Color fundus image · 50-degree field of view.
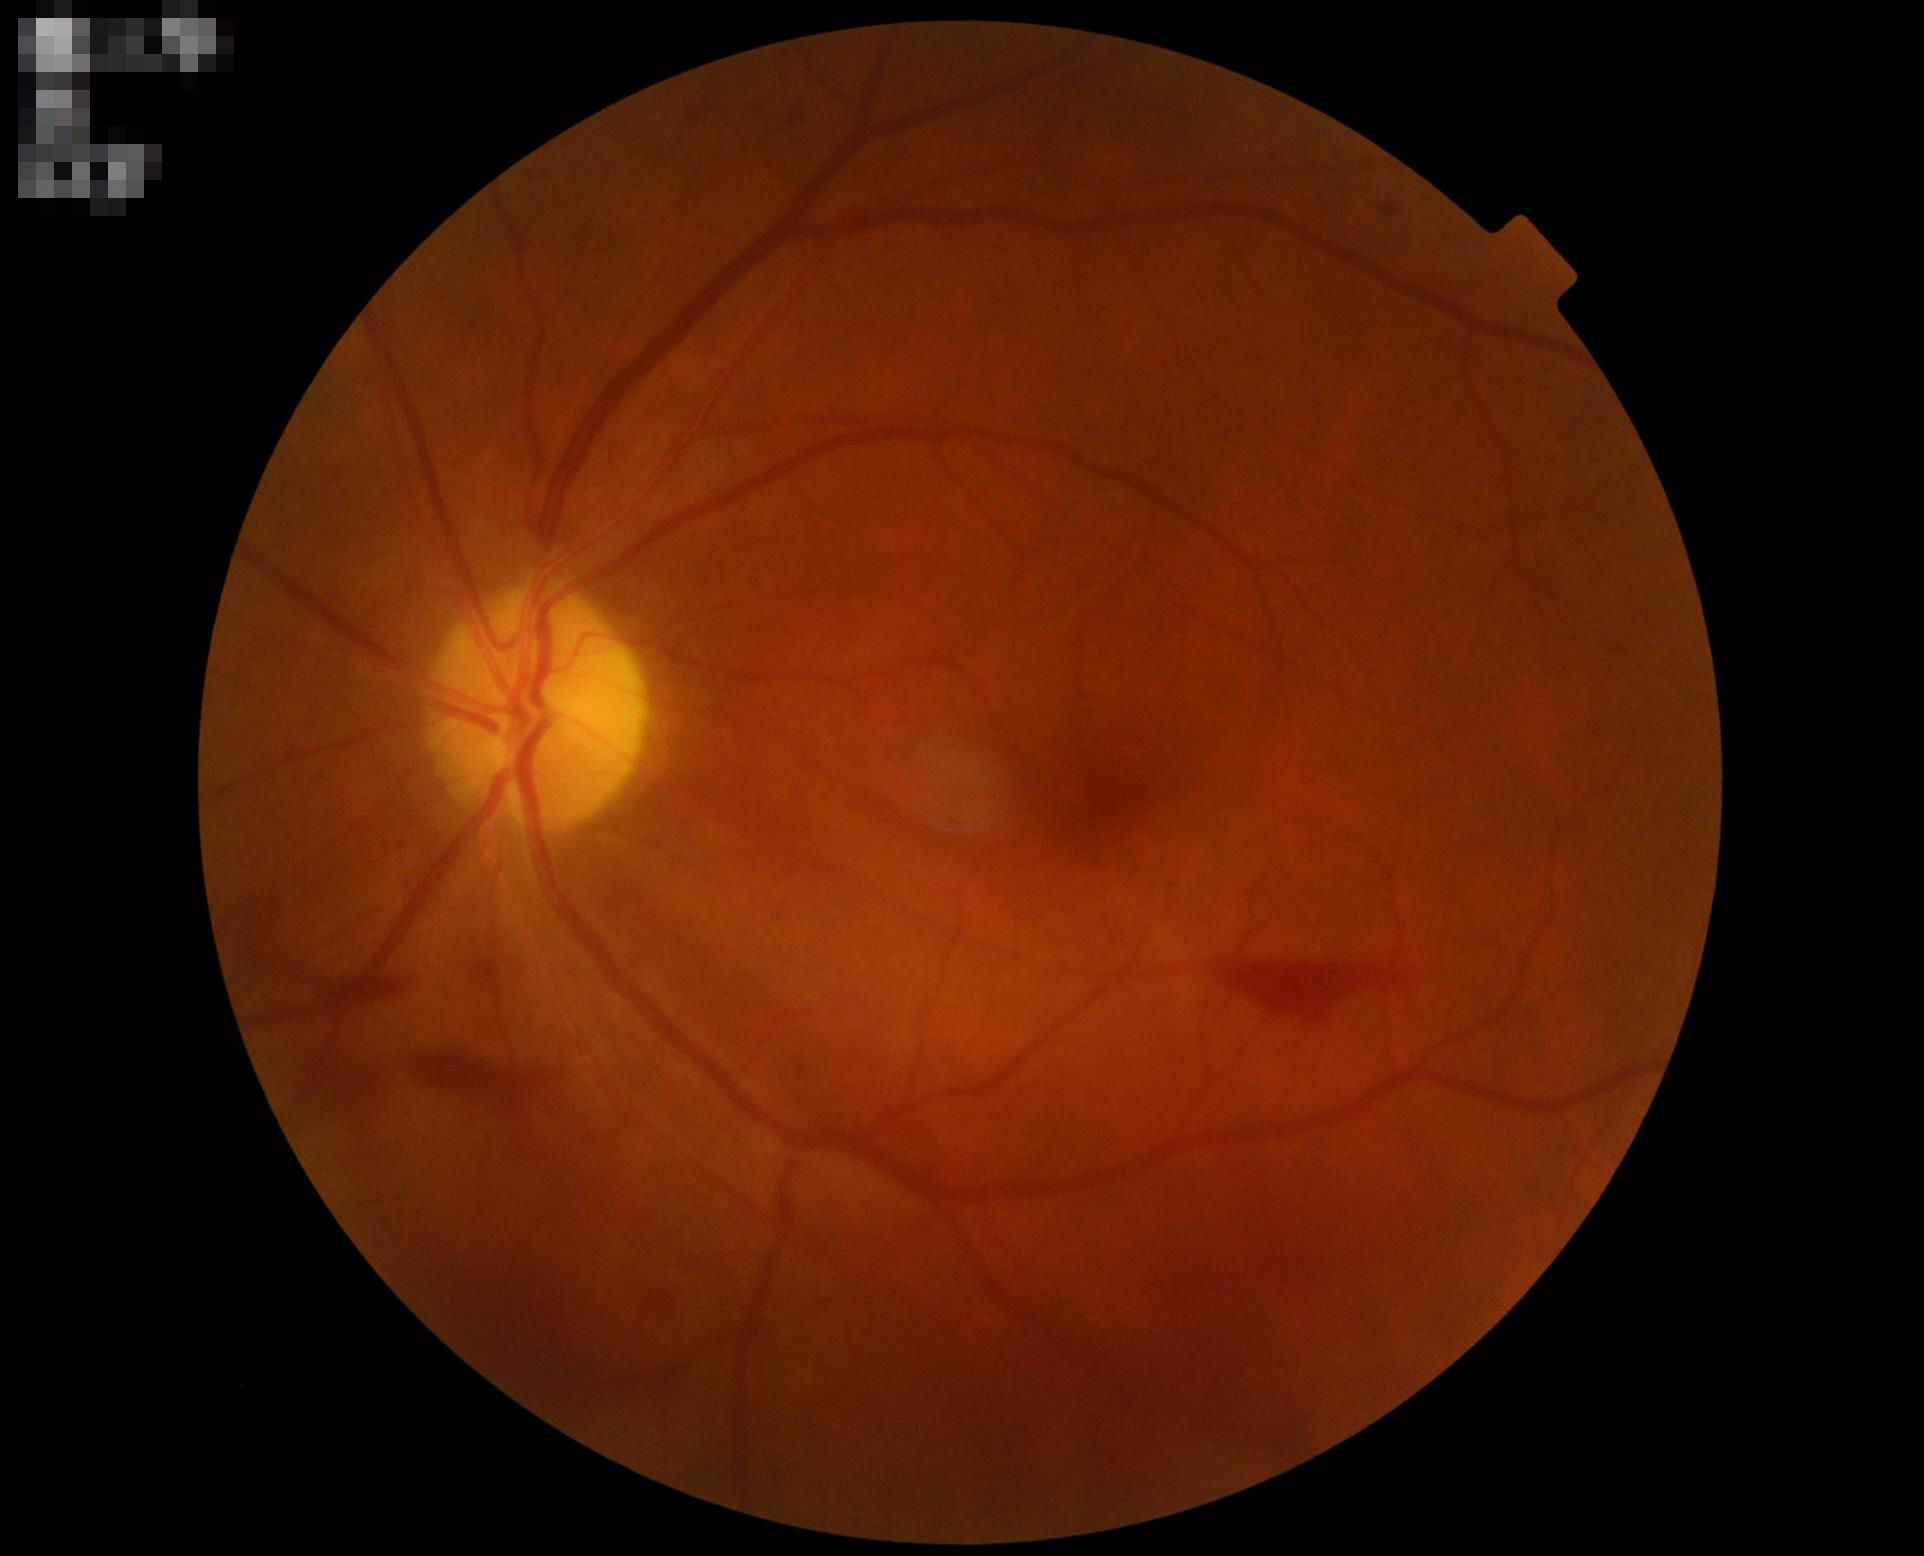
No over- or under-exposure. Image quality is adequate for diagnostic use. No noticeable blur.